Fundus photo: 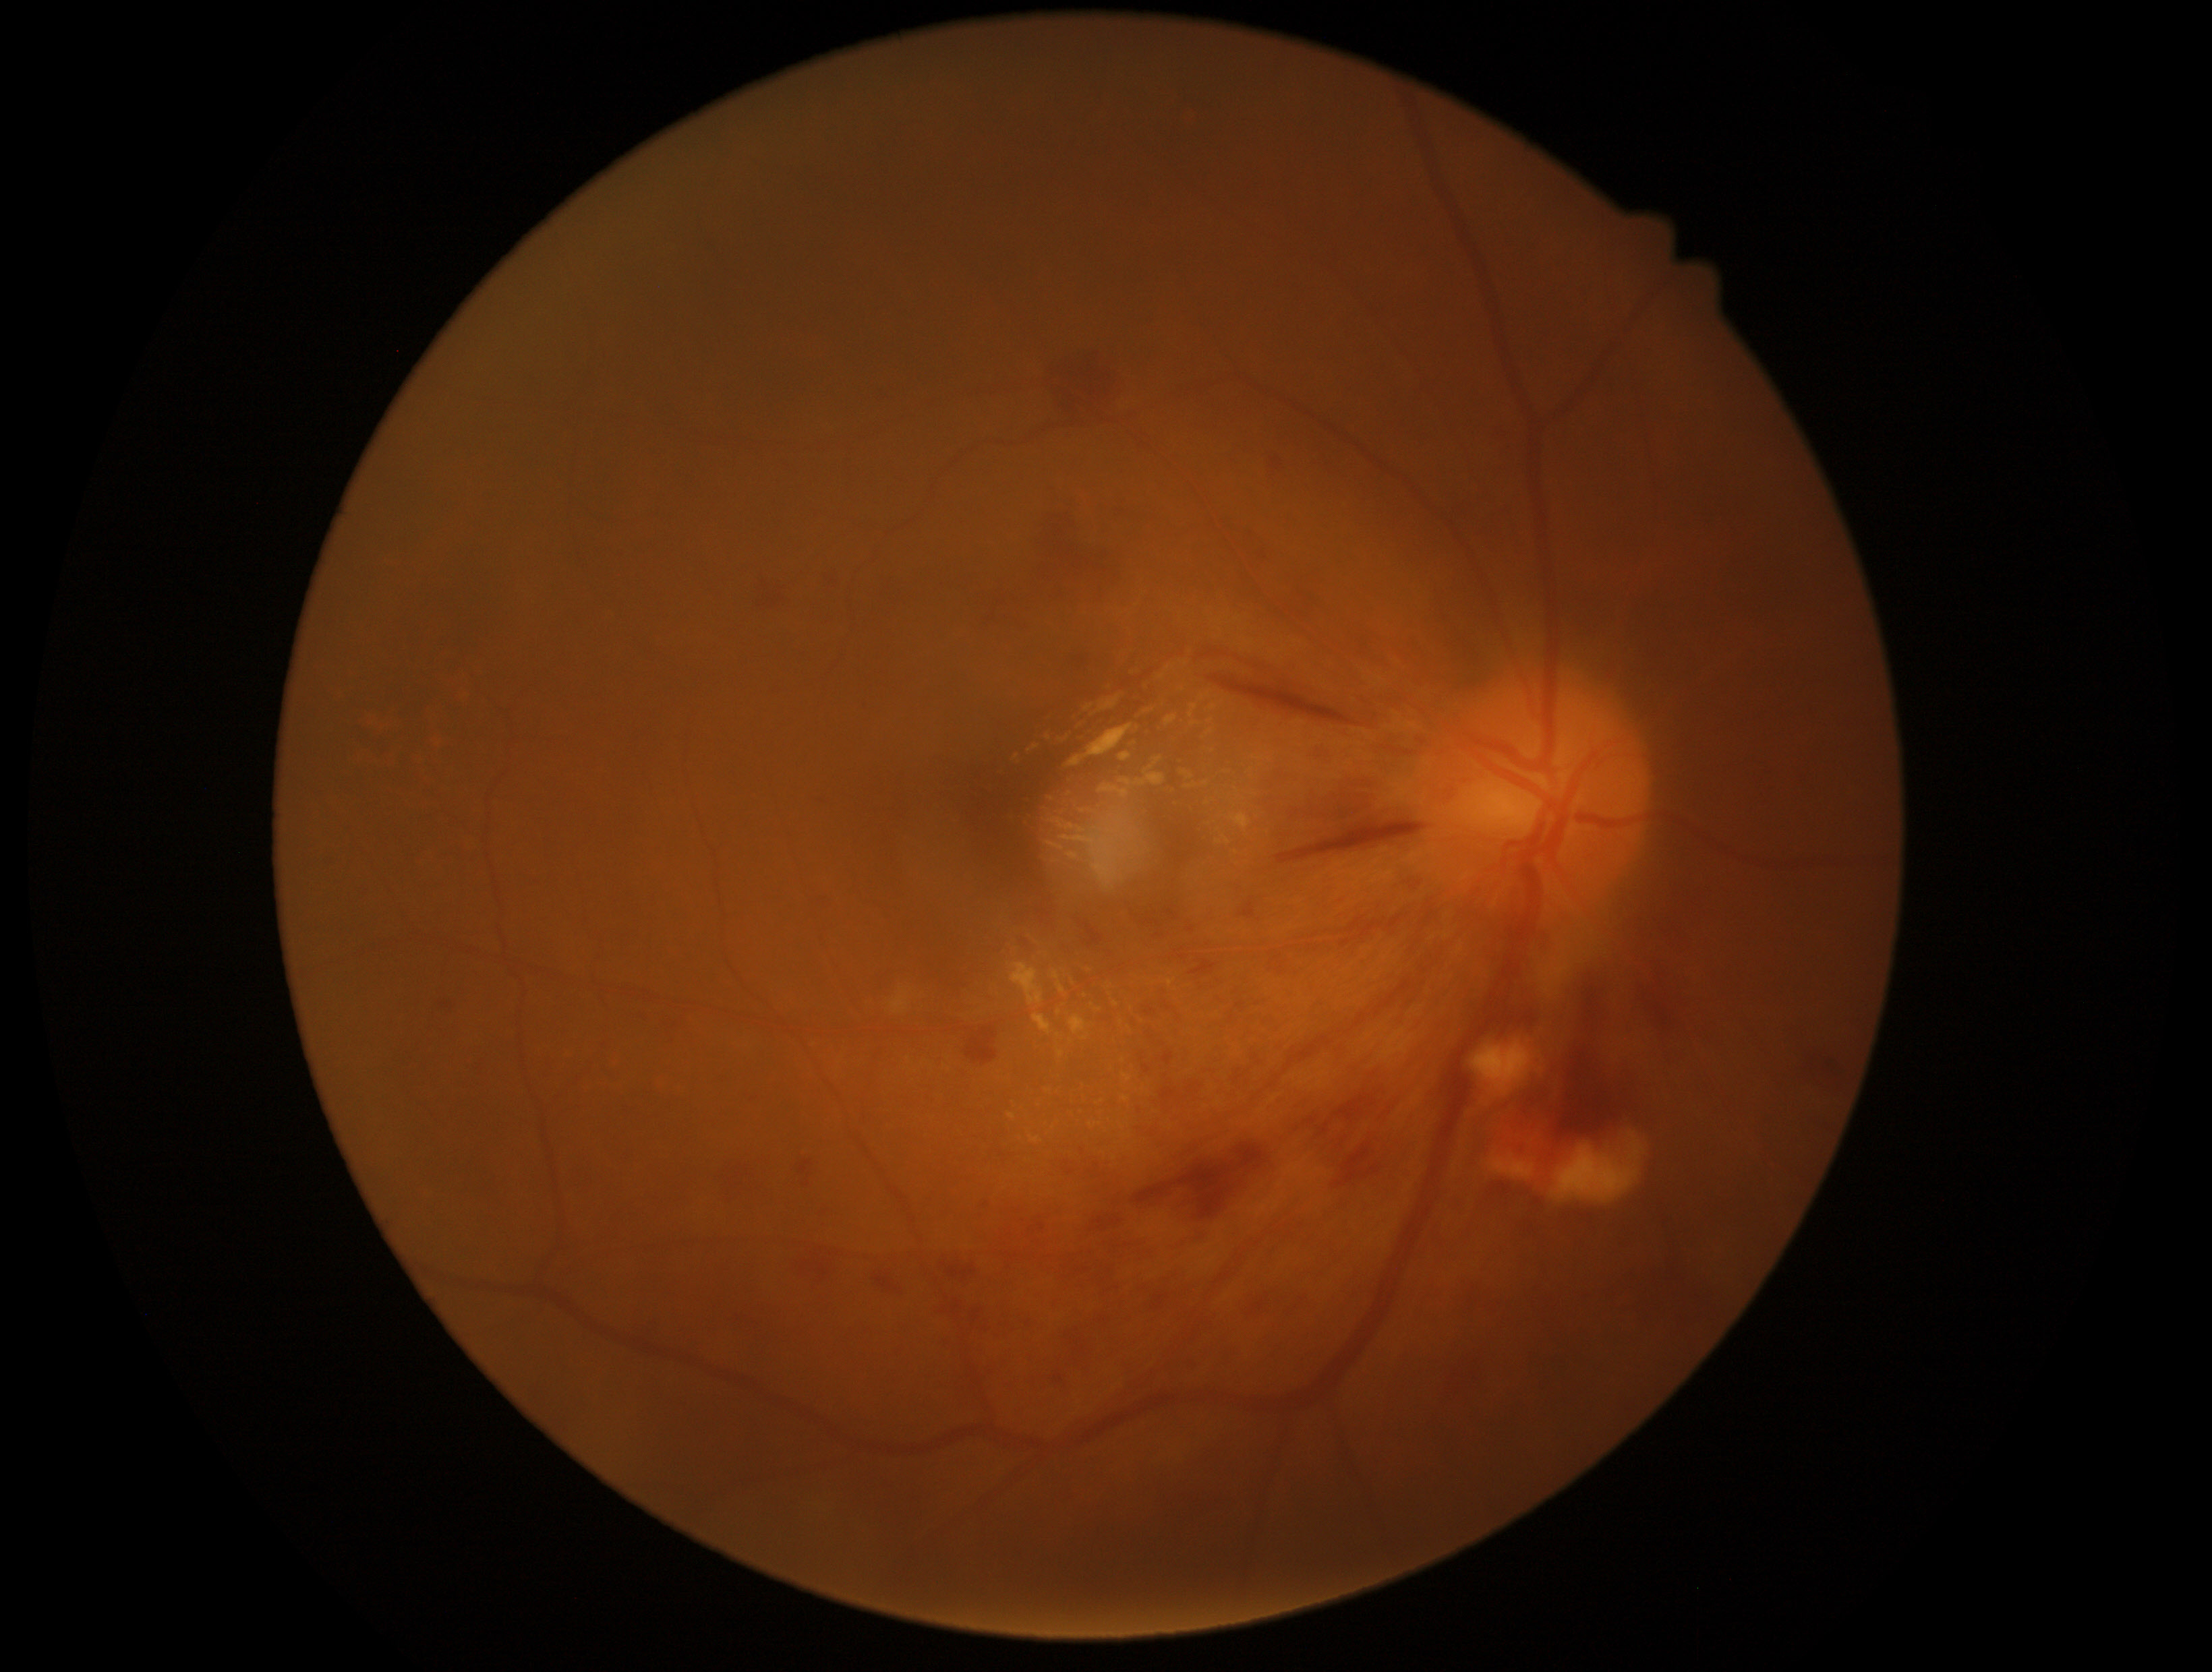 - diabetic retinopathy (DR) — grade 2